Modified Davis classification
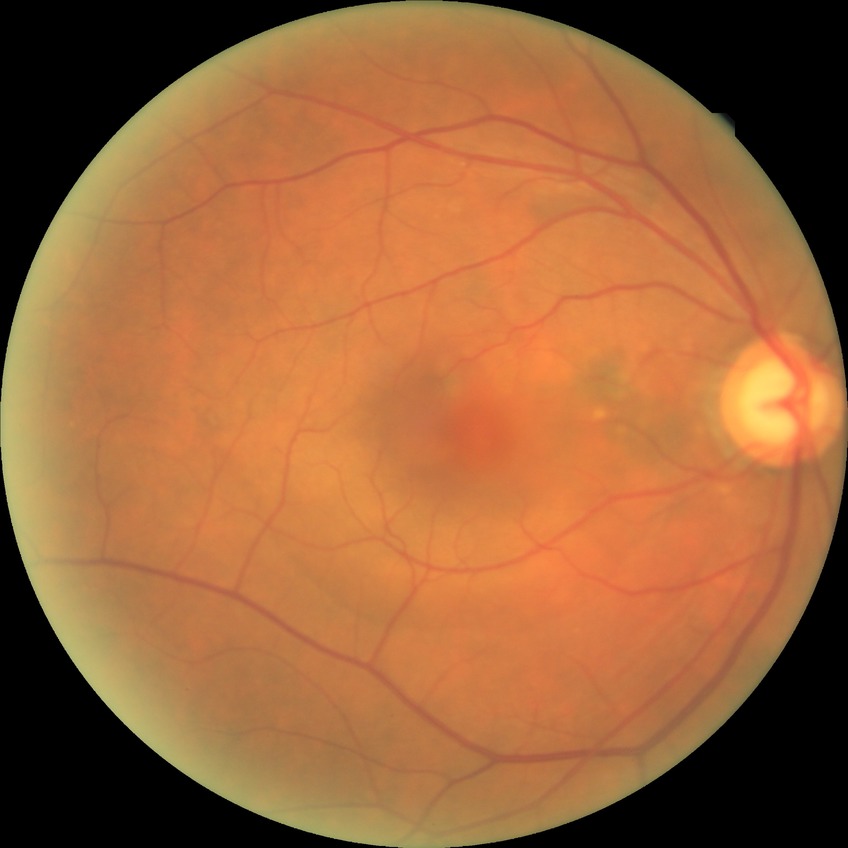 diabetic retinopathy stage=no diabetic retinopathy.